Acquired with a Topcon TRC-50DX. FOV: 50 degrees — 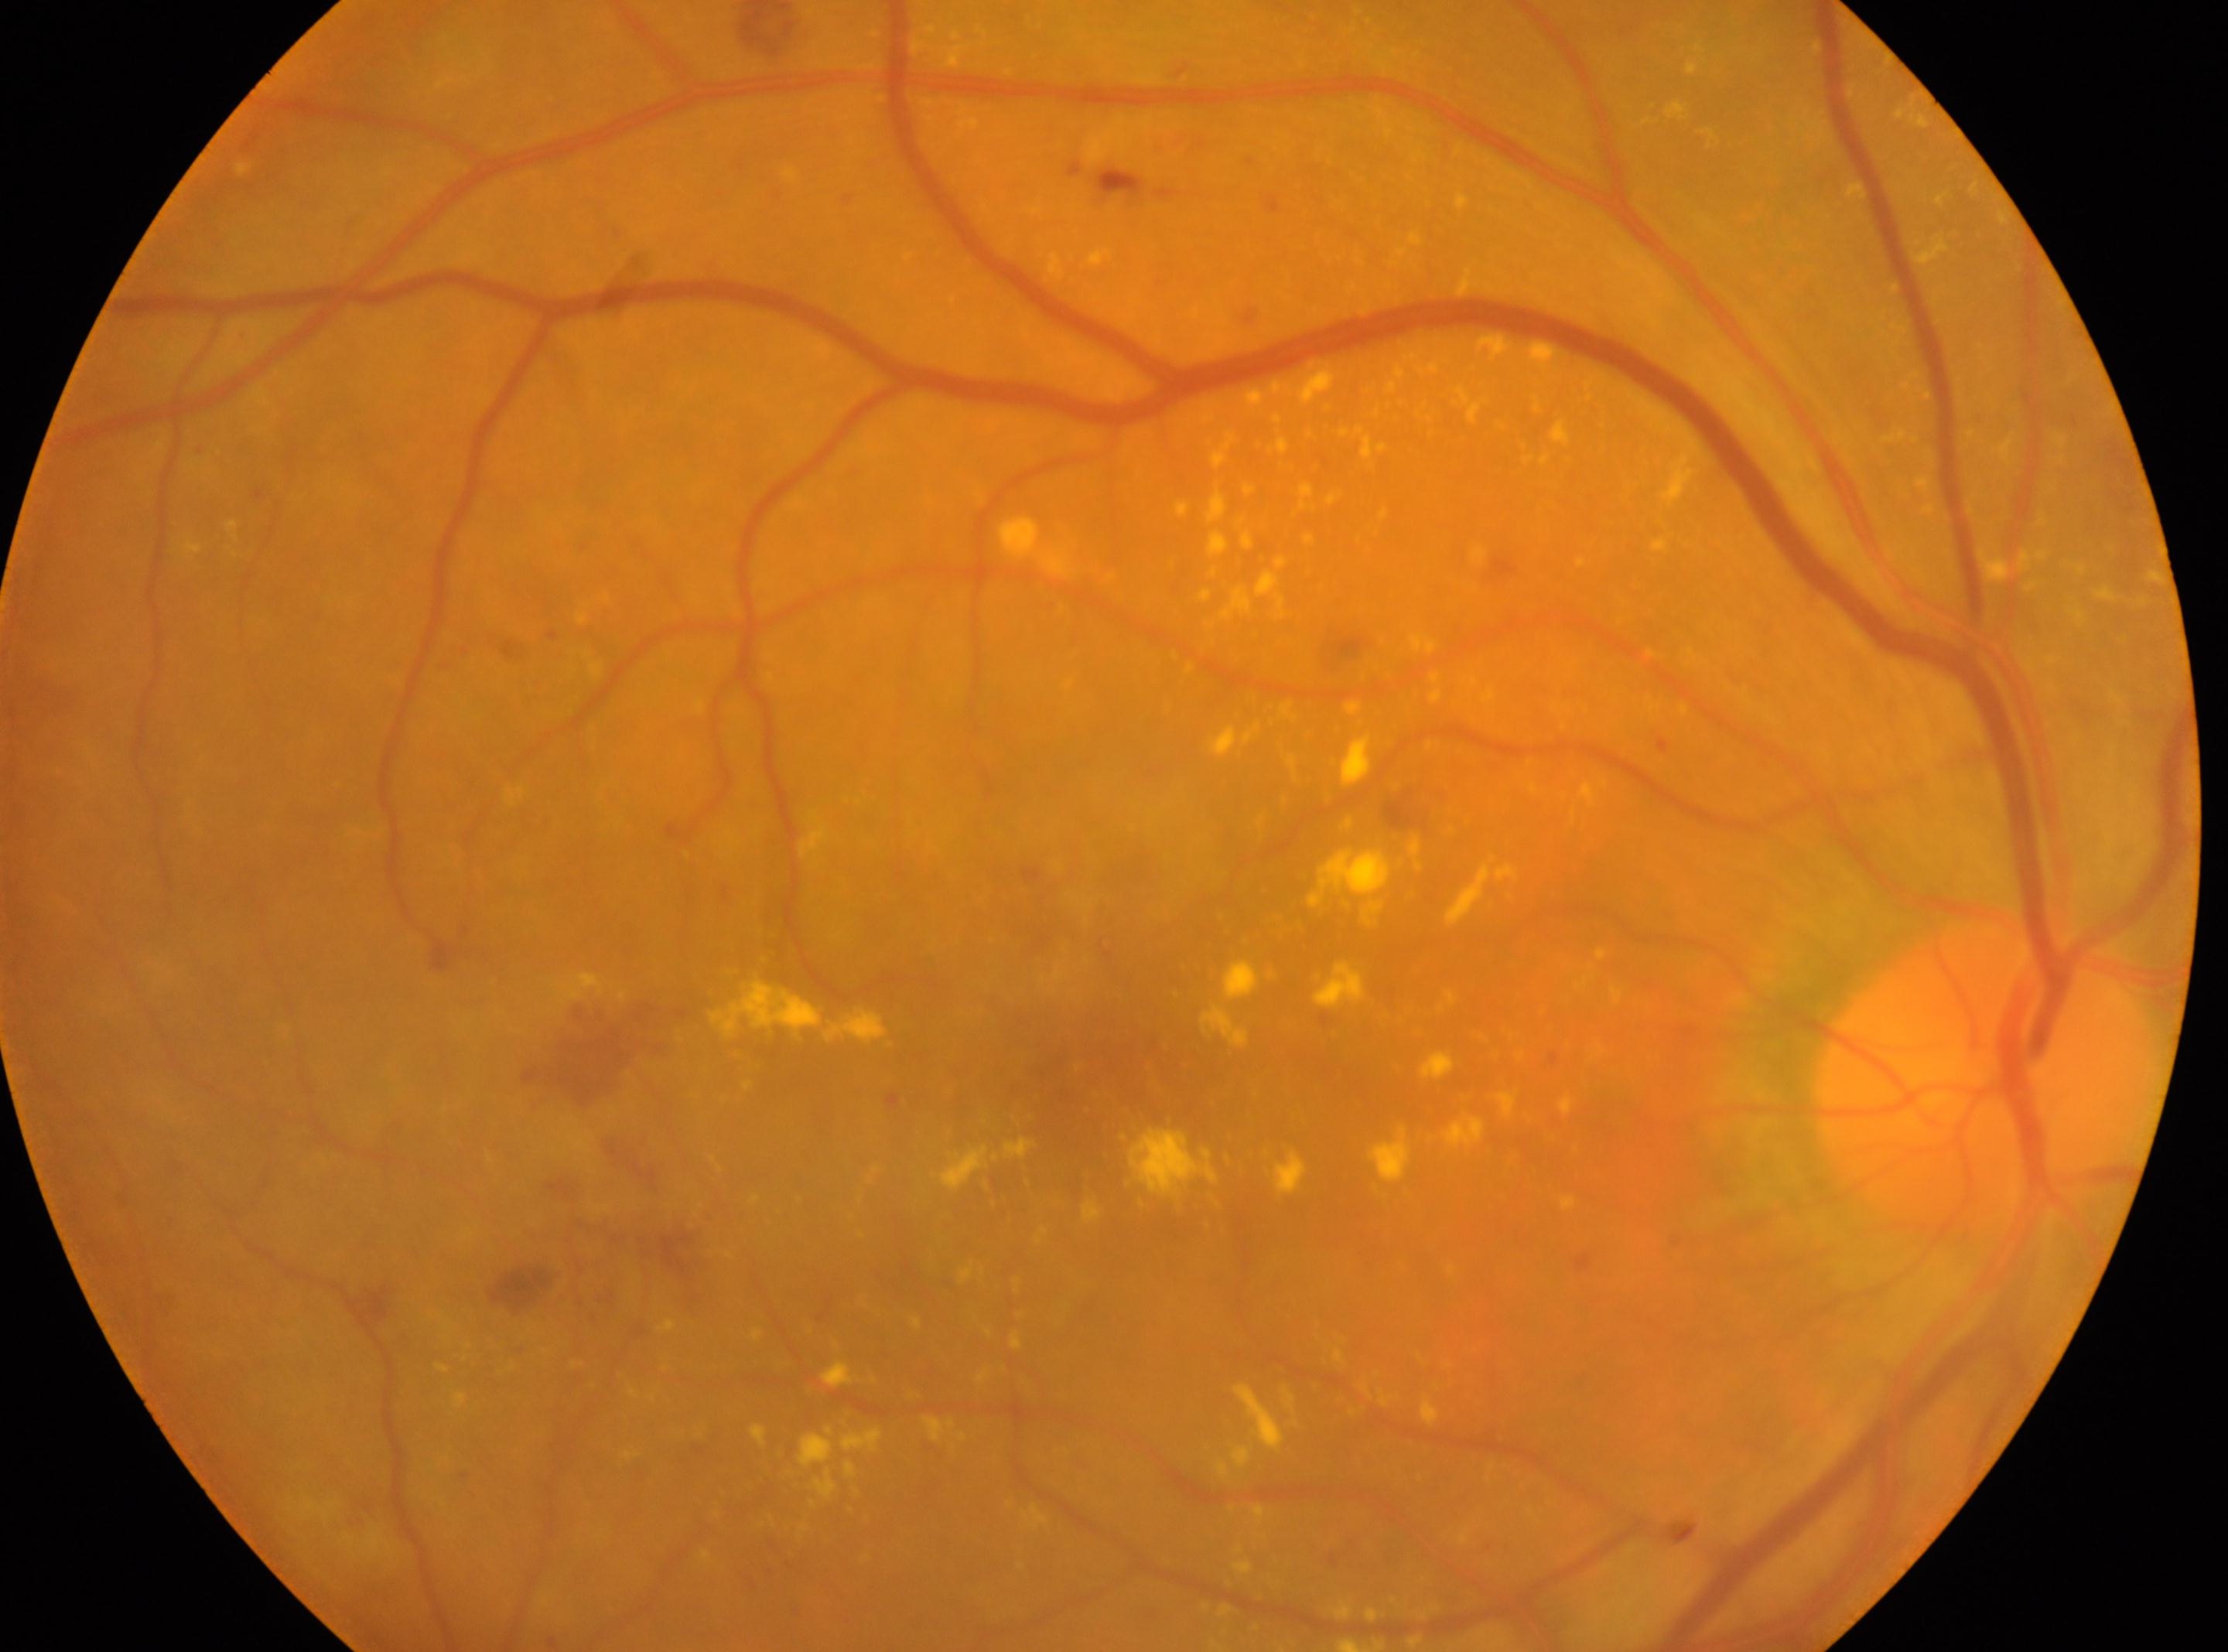 | key | value |
|---|---|
| foveal center | x=1100, y=1097 |
| the optic disc | x=1982, y=1083 |
| DR severity | 2/4 |
| laterality | oculus dexter |